848 x 848 pixels; modified Davis grading:
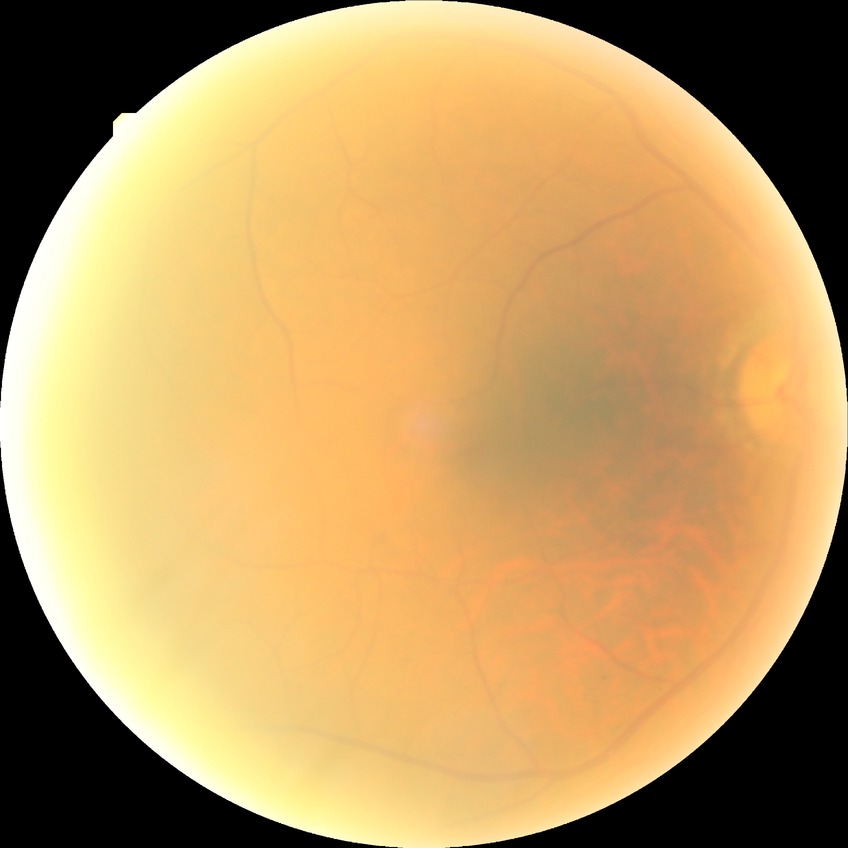

  davis_grade: no diabetic retinopathy